Pediatric wide-field fundus photograph; 640x480px.
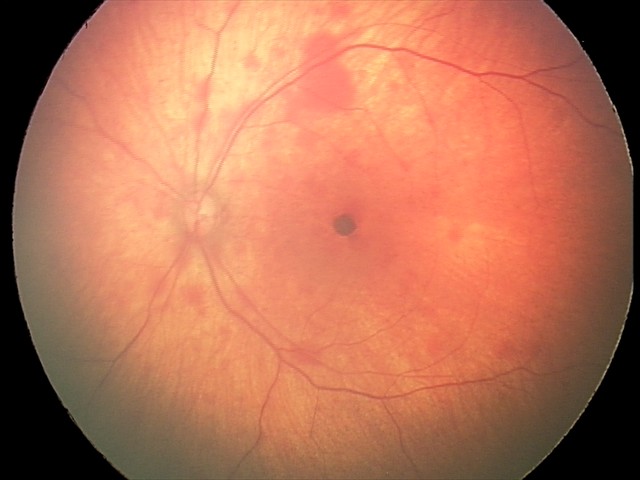

From an examination with diagnosis of retinal hemorrhages.